Portable fundus photograph — 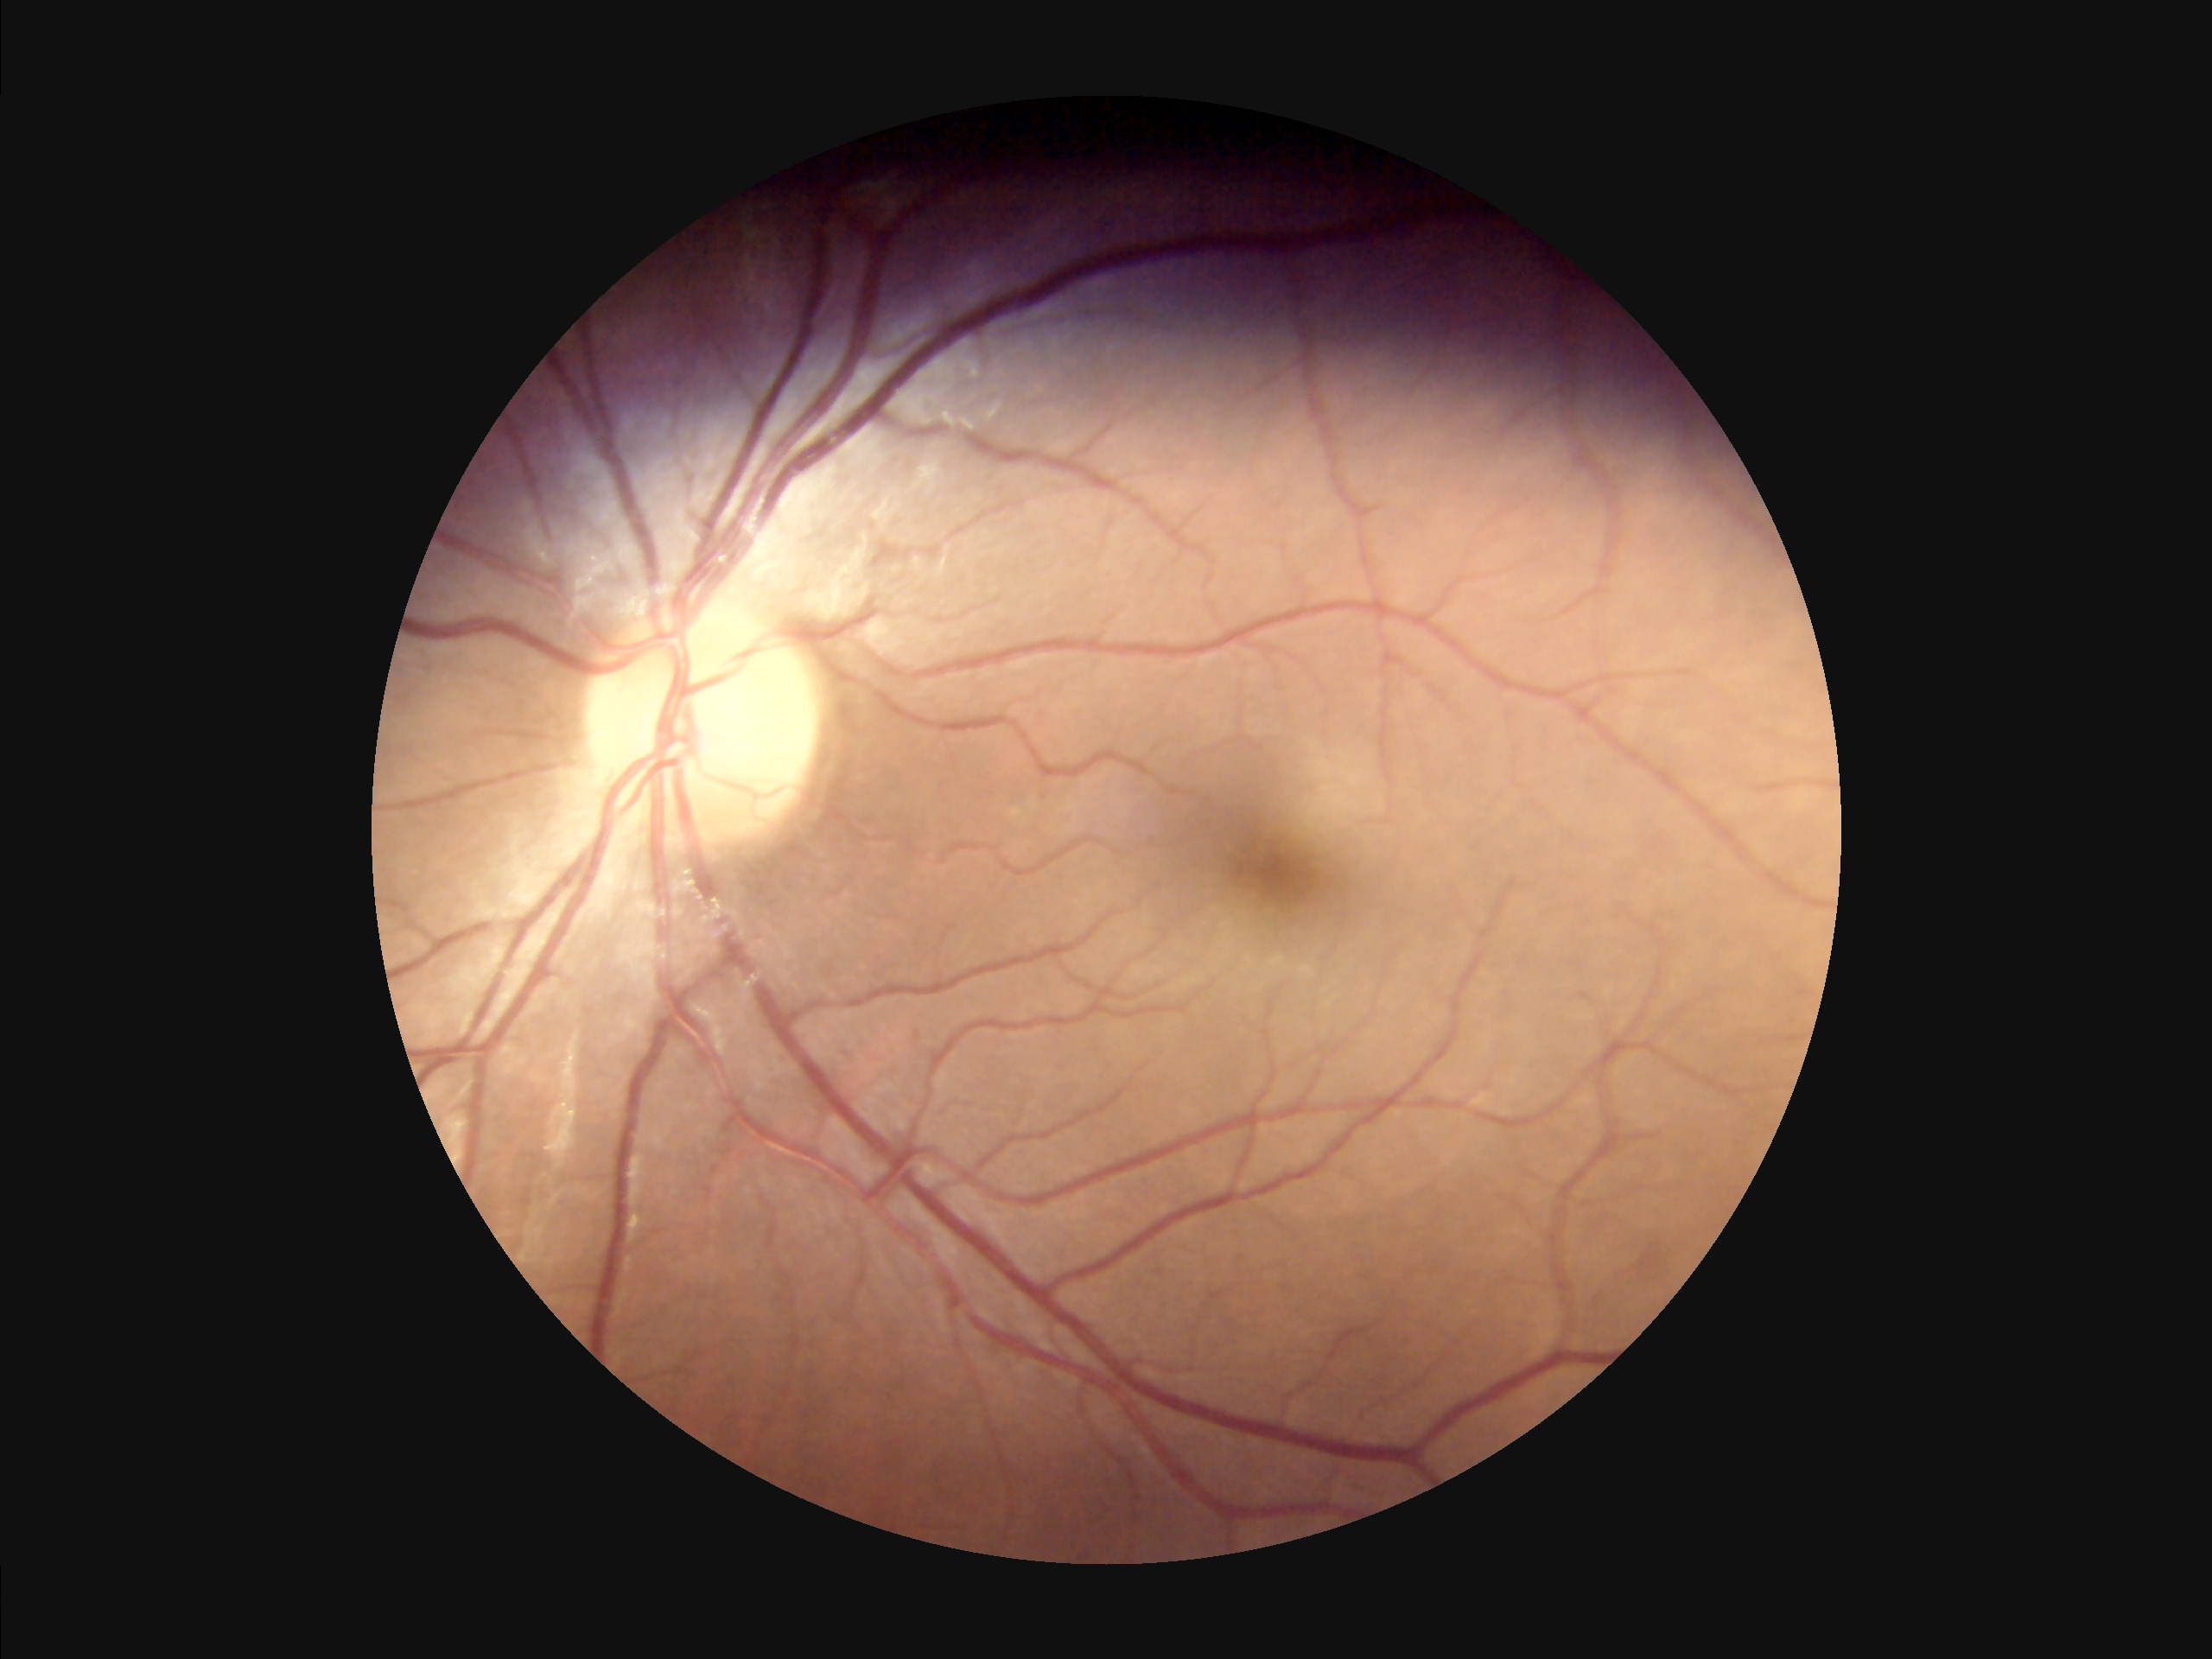
No noticeable blur.
Poor illumination with uneven exposure.
Overall quality is good and the image is gradable.
Adequate contrast for distinguishing structures.